Wide-field fundus photograph of an infant · 640 by 480 pixels.
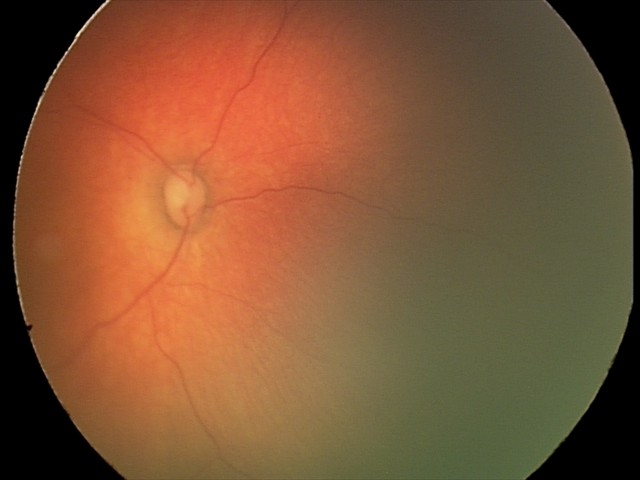 Screening examination diagnosed as physiological.